Wide-field fundus photograph of an infant
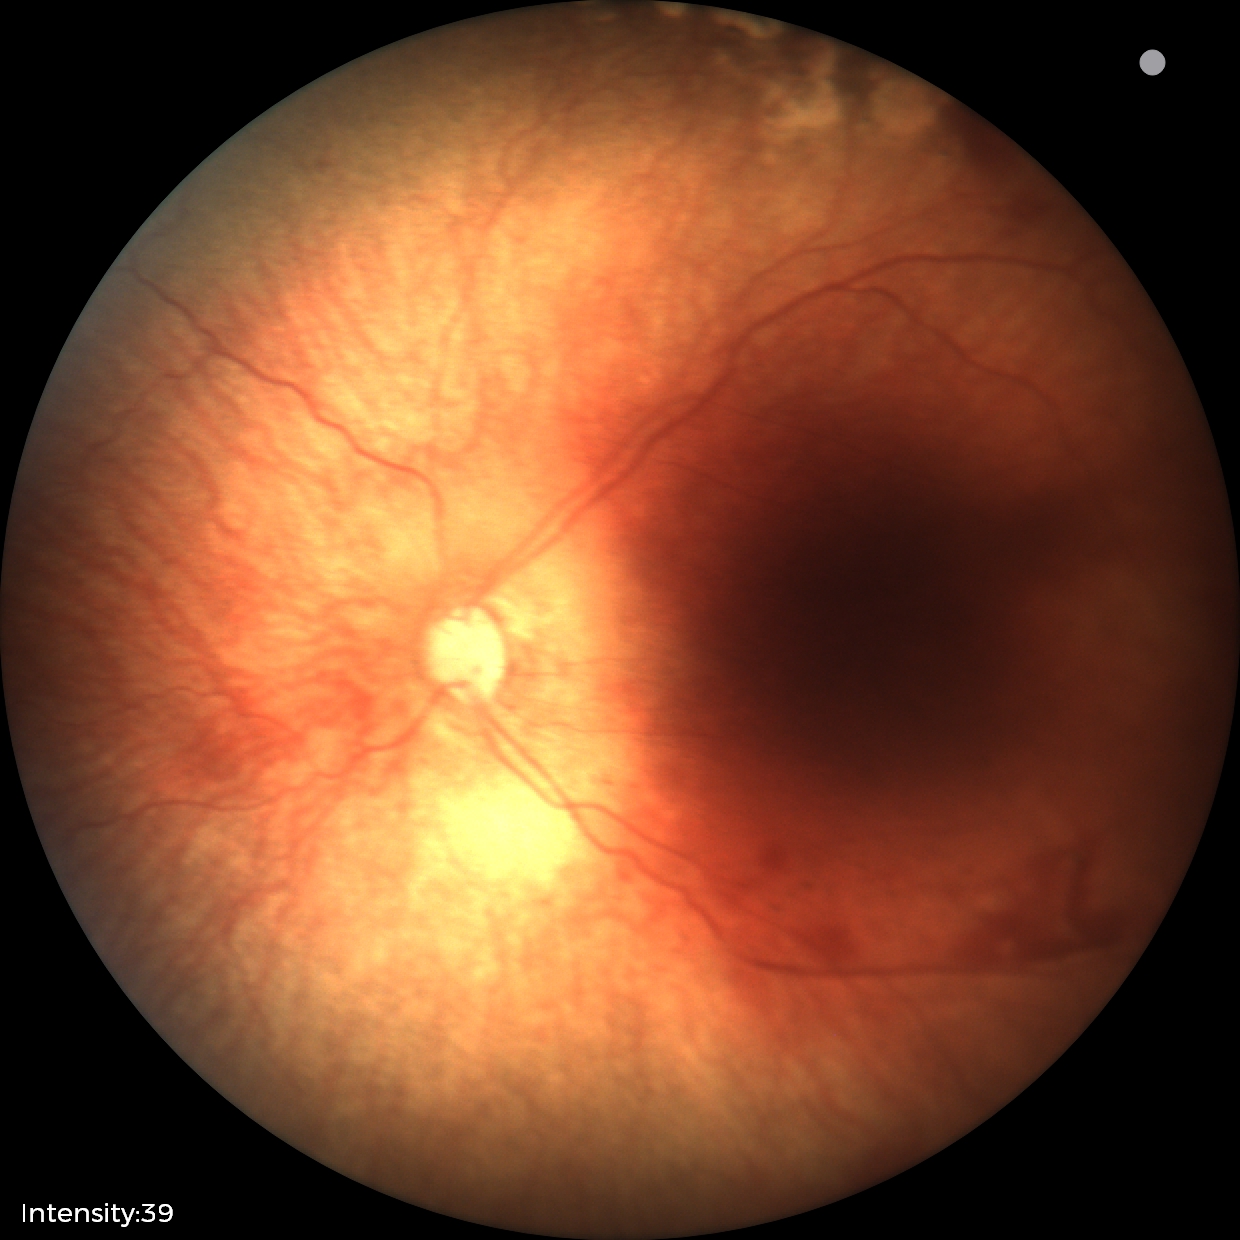

Series diagnosed as status post retinopathy of prematurity — retinal appearance after treated retinopathy of prematurity.
No plus disease.